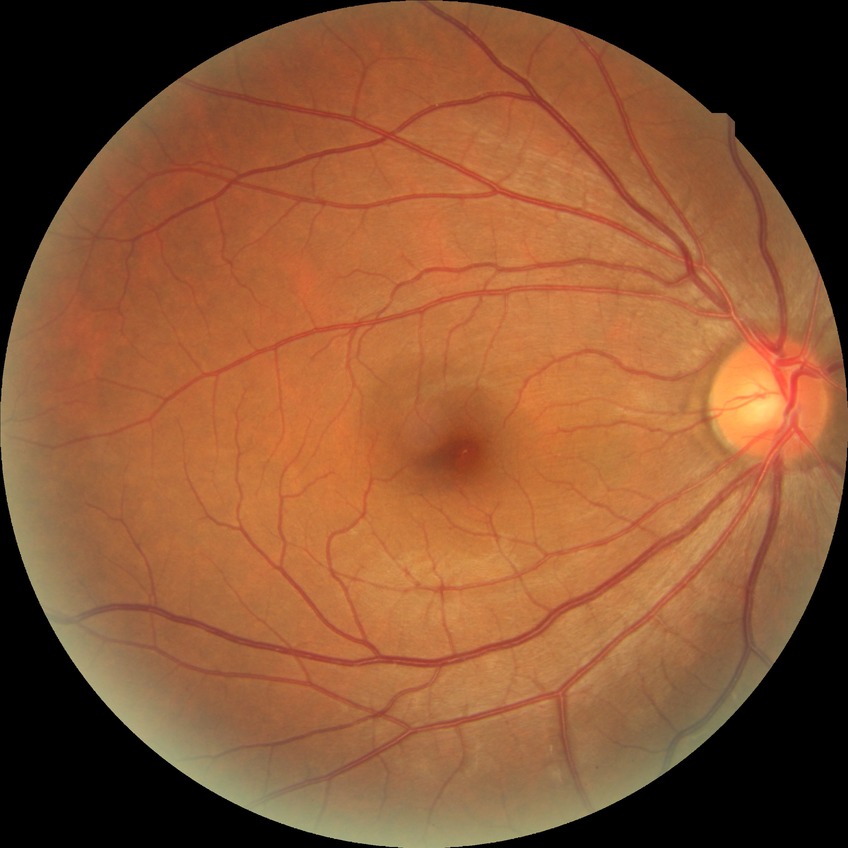

Davis DR grade: NDR.